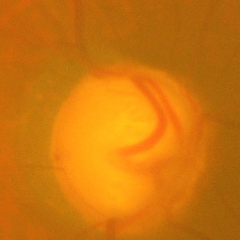 Glaucomatous optic neuropathy is present.
Severe glaucomatous damage.